2184 by 1690 pixels; fundus photo:
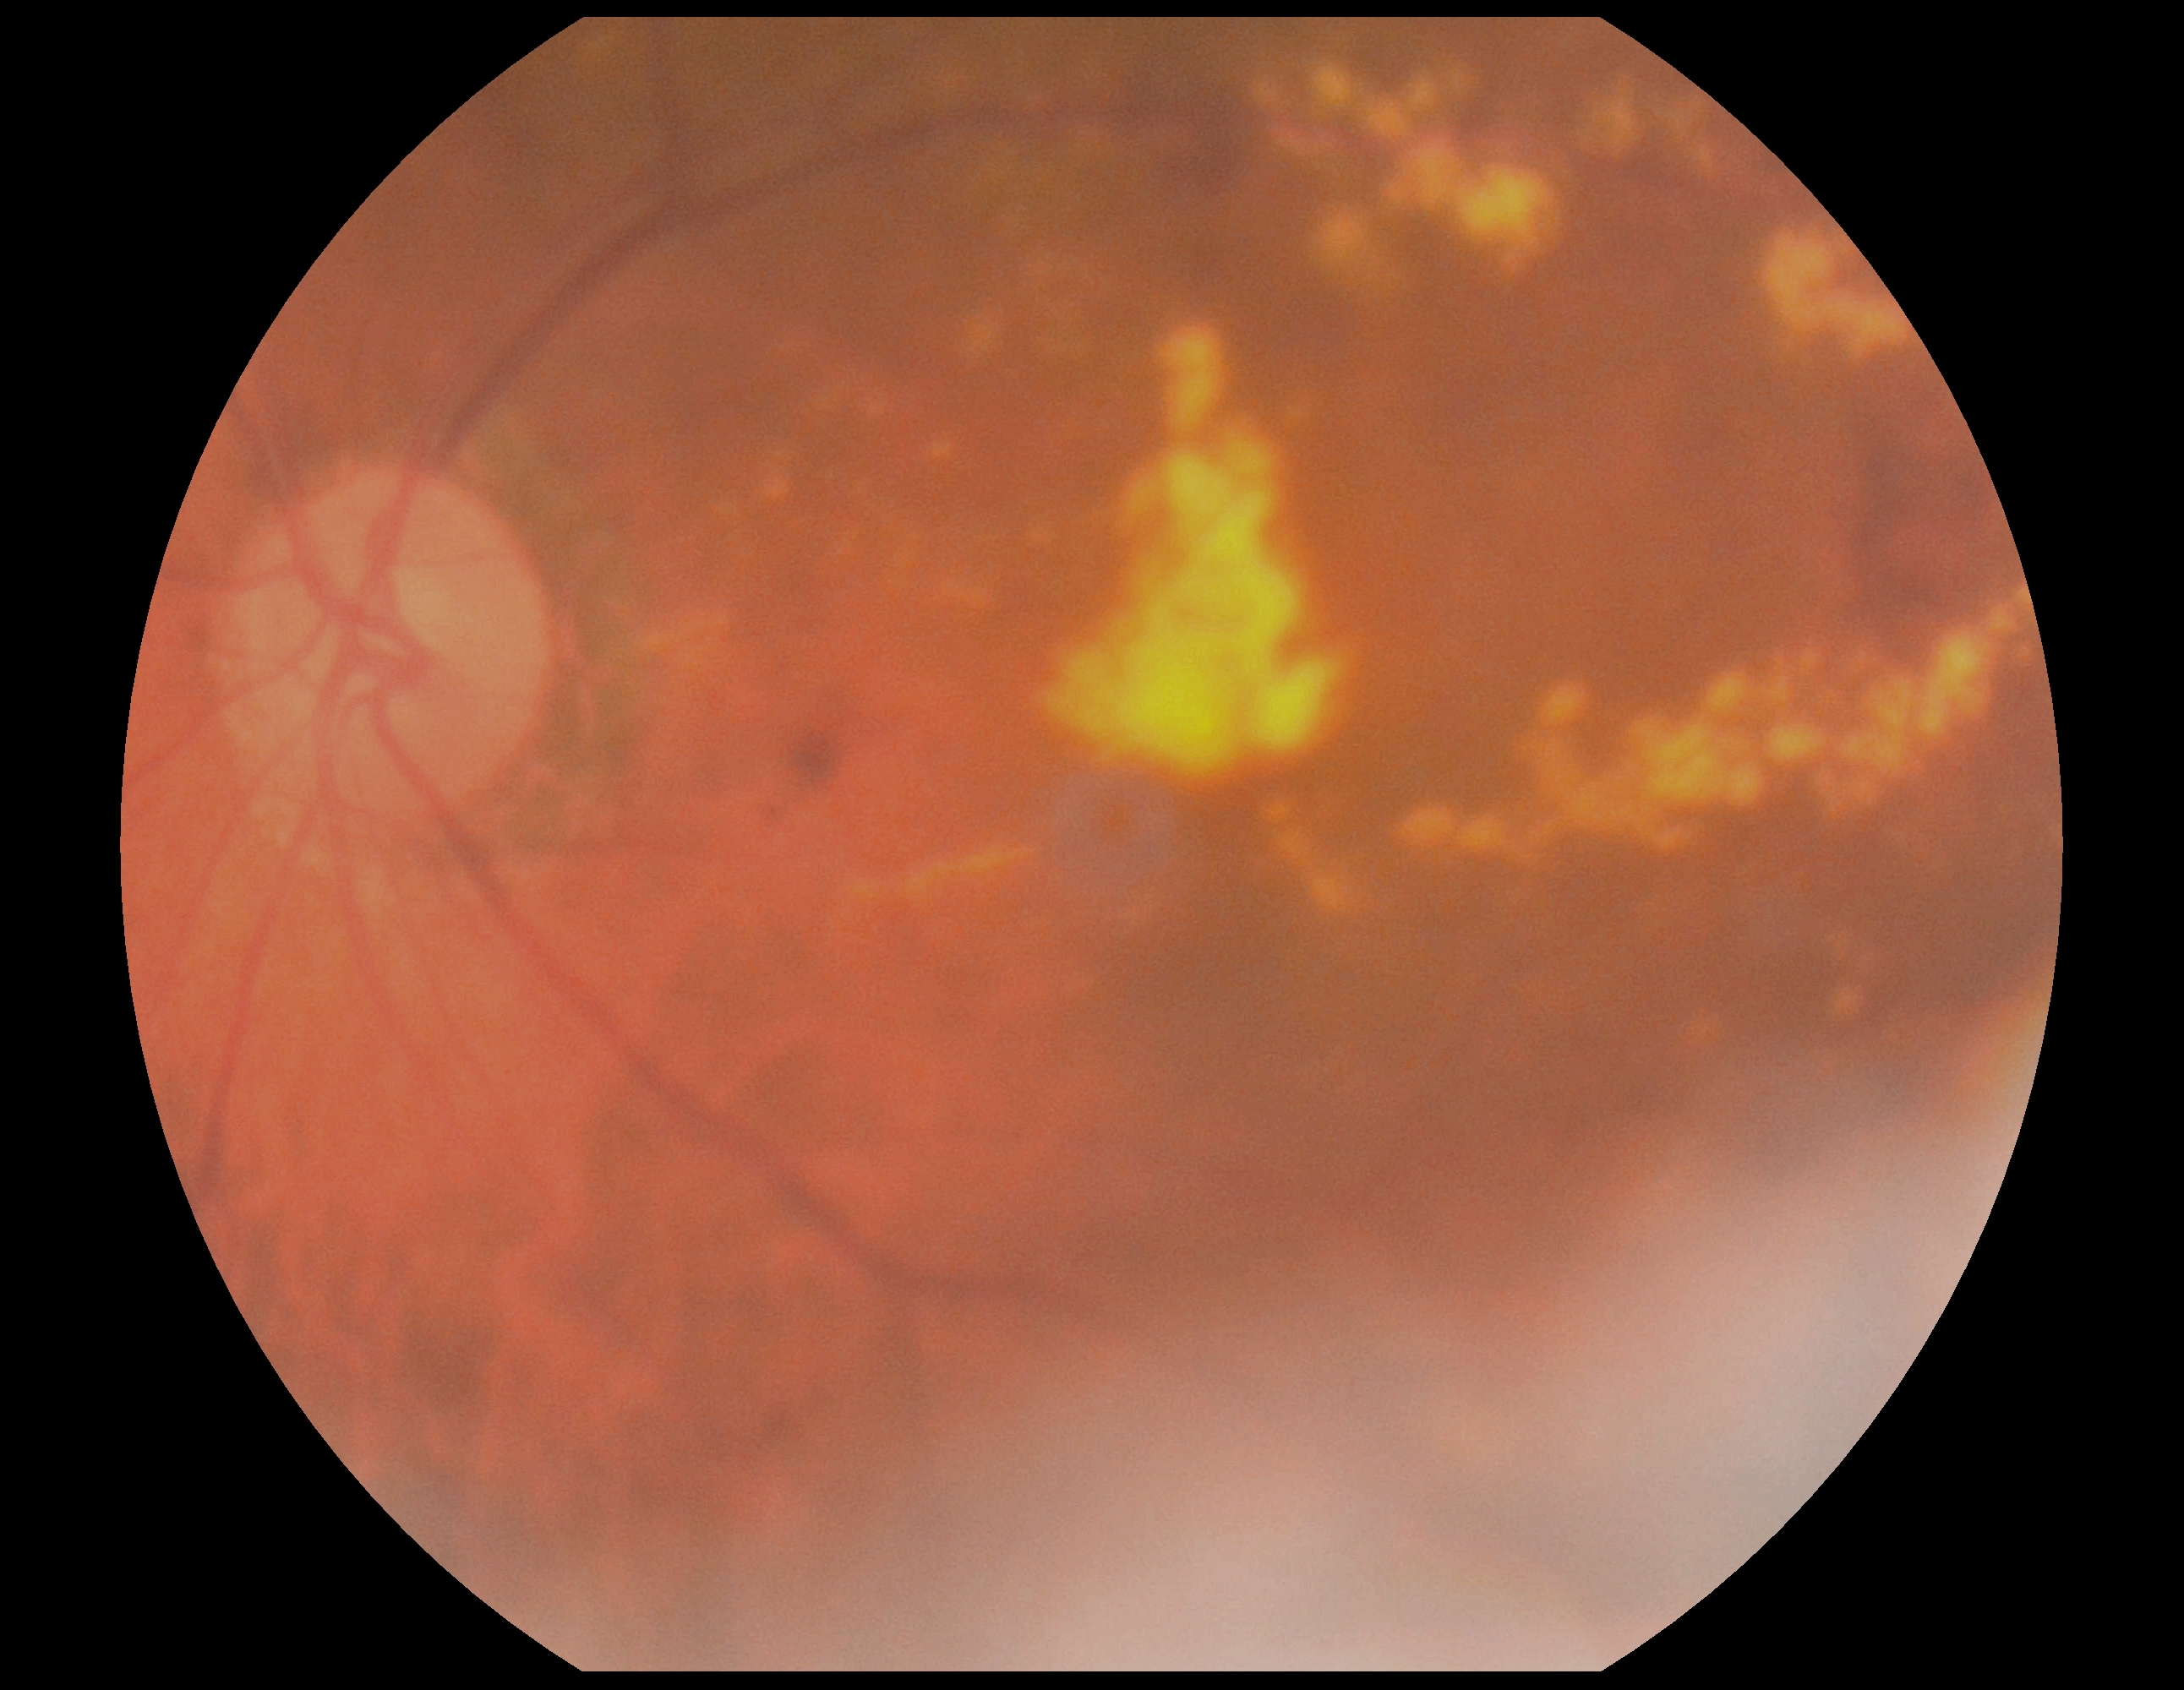

DR: moderate non-proliferative diabetic retinopathy (grade 2).